2089 by 1764 pixels: 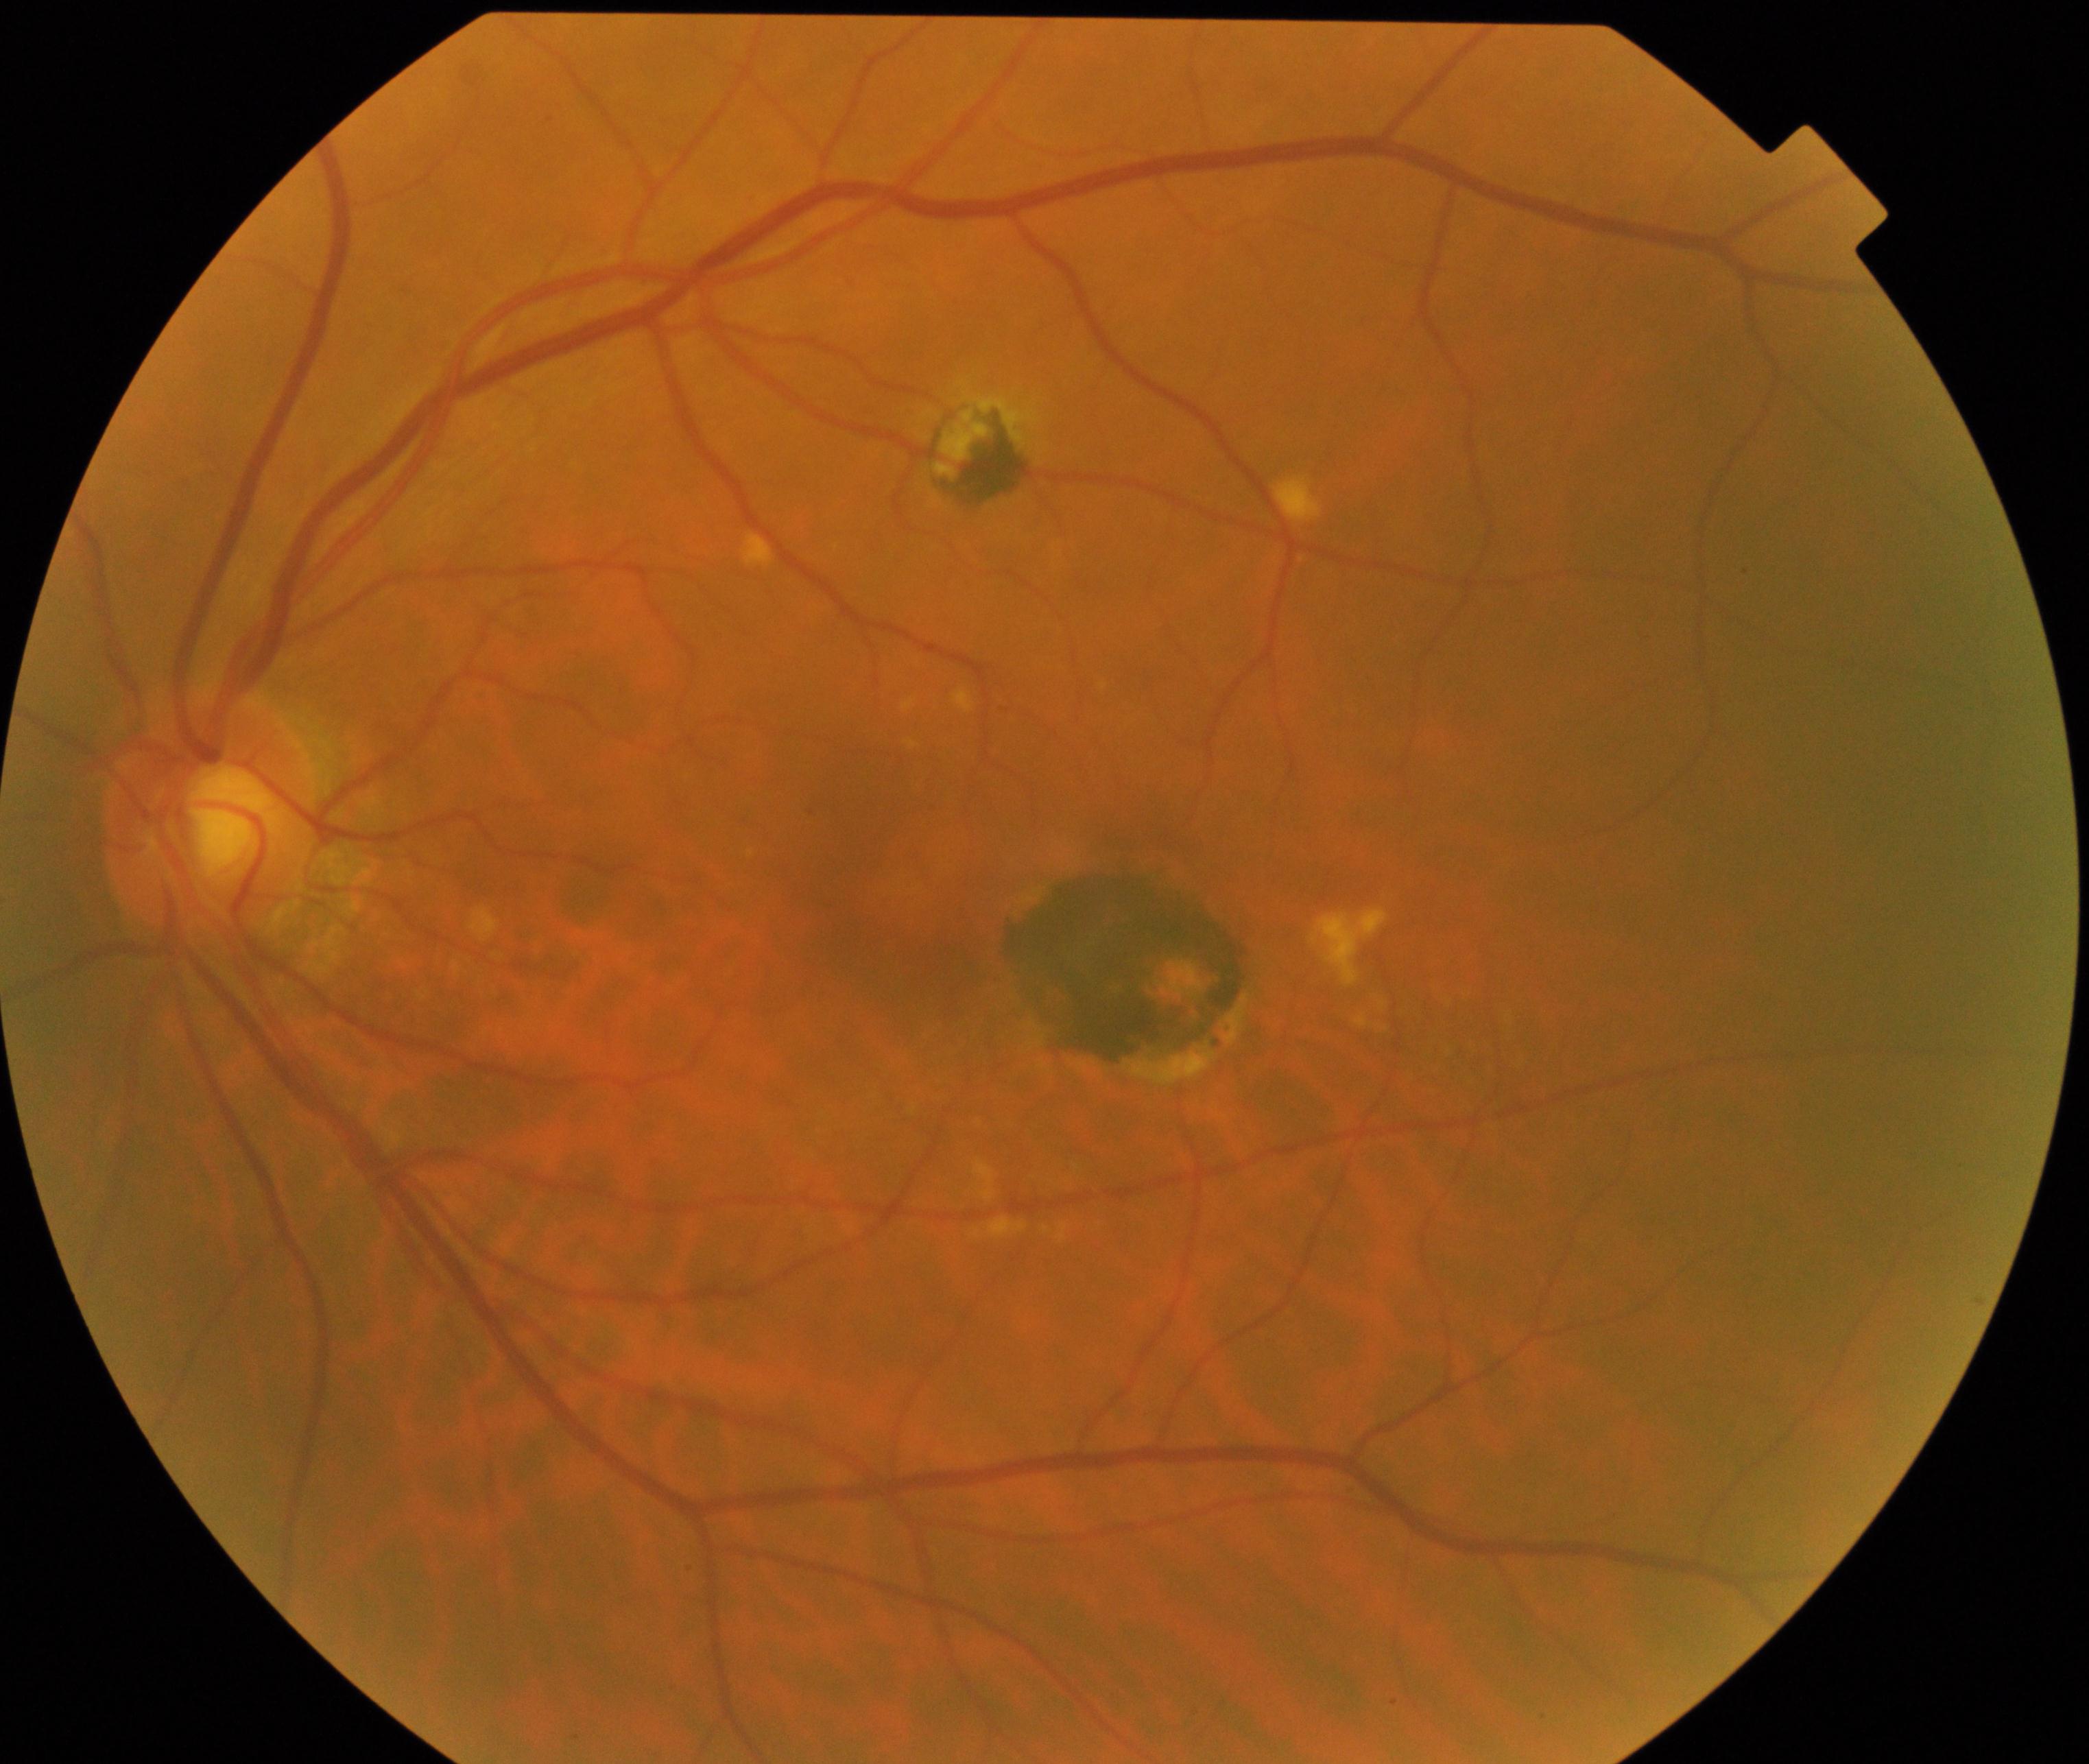 There is evidence of maculopathy. Typically showing lesions within the macular area, such as intermediate or neovascular age-related macular degeneration, retinal angiomatous proliferation, polypoidal choroidal vasculopathy, choroidal neovascularization, idiopathic macular telangiectasia, and macular atrophy, not caused by other listed disease categories.